240 x 240 pixels · disc-centered field.
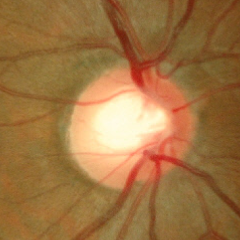 No signs of glaucoma.